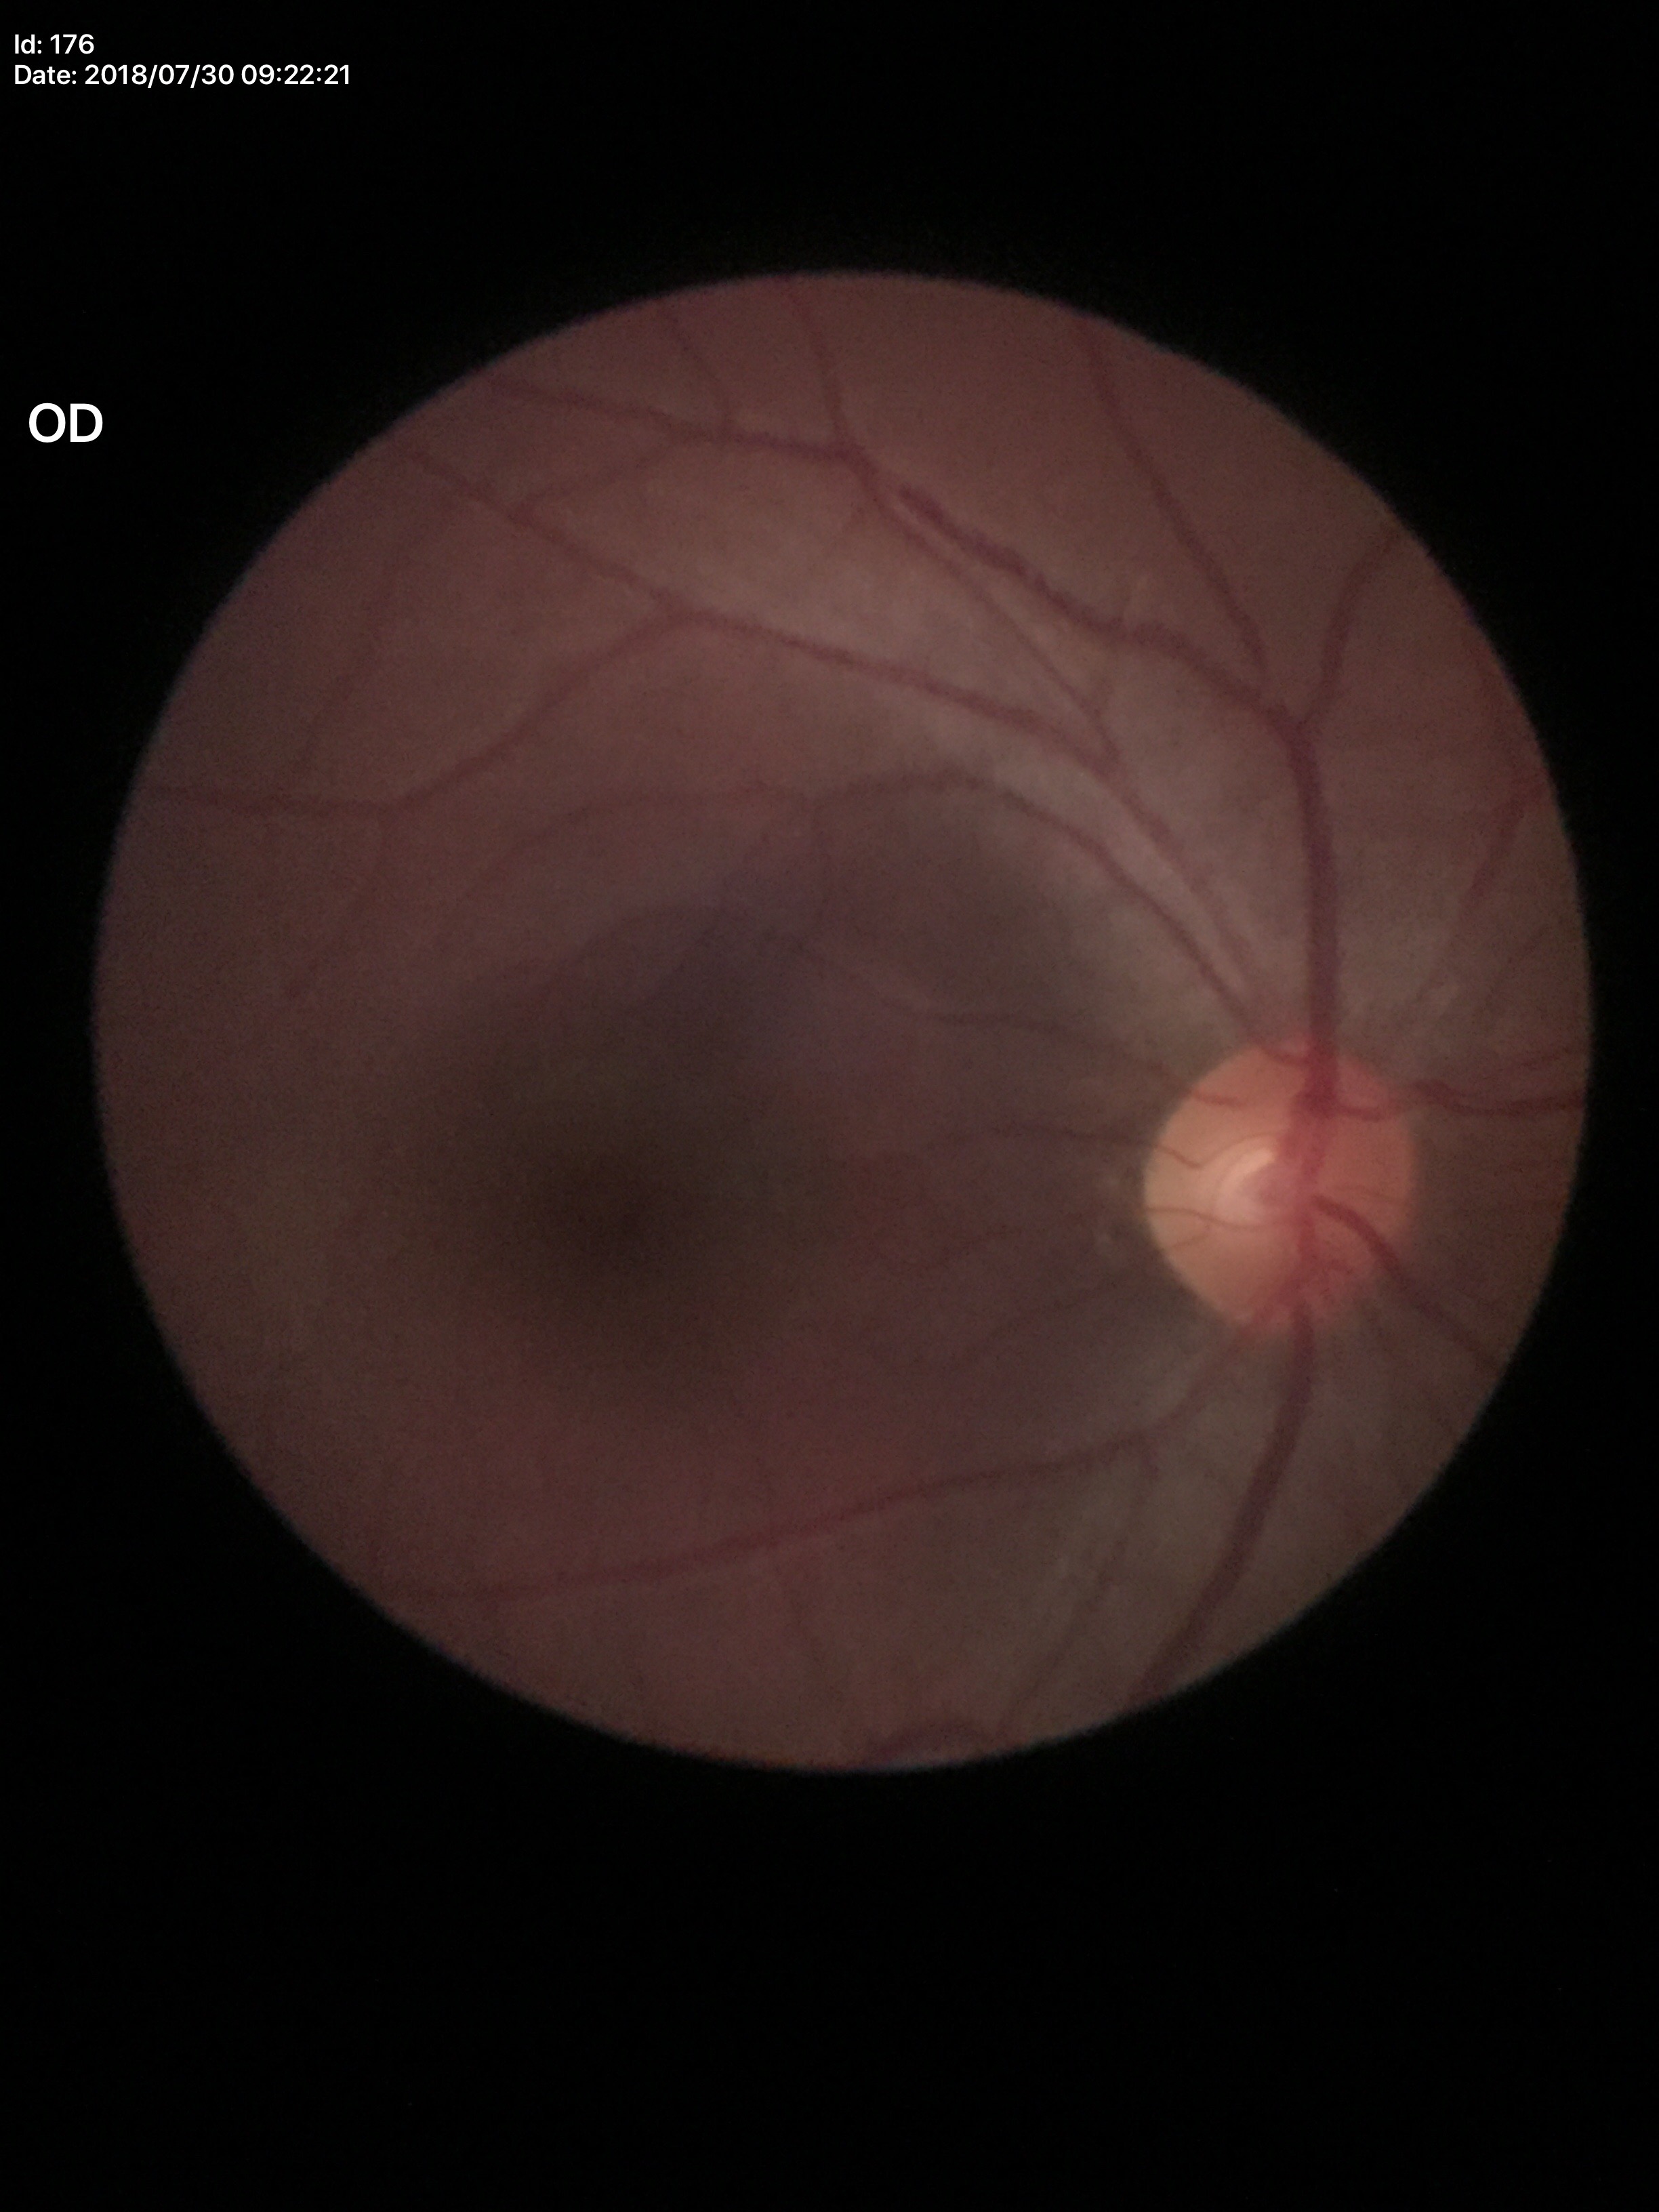

  glaucoma_decision: negative
  vcdr: 0.48